2352x1568
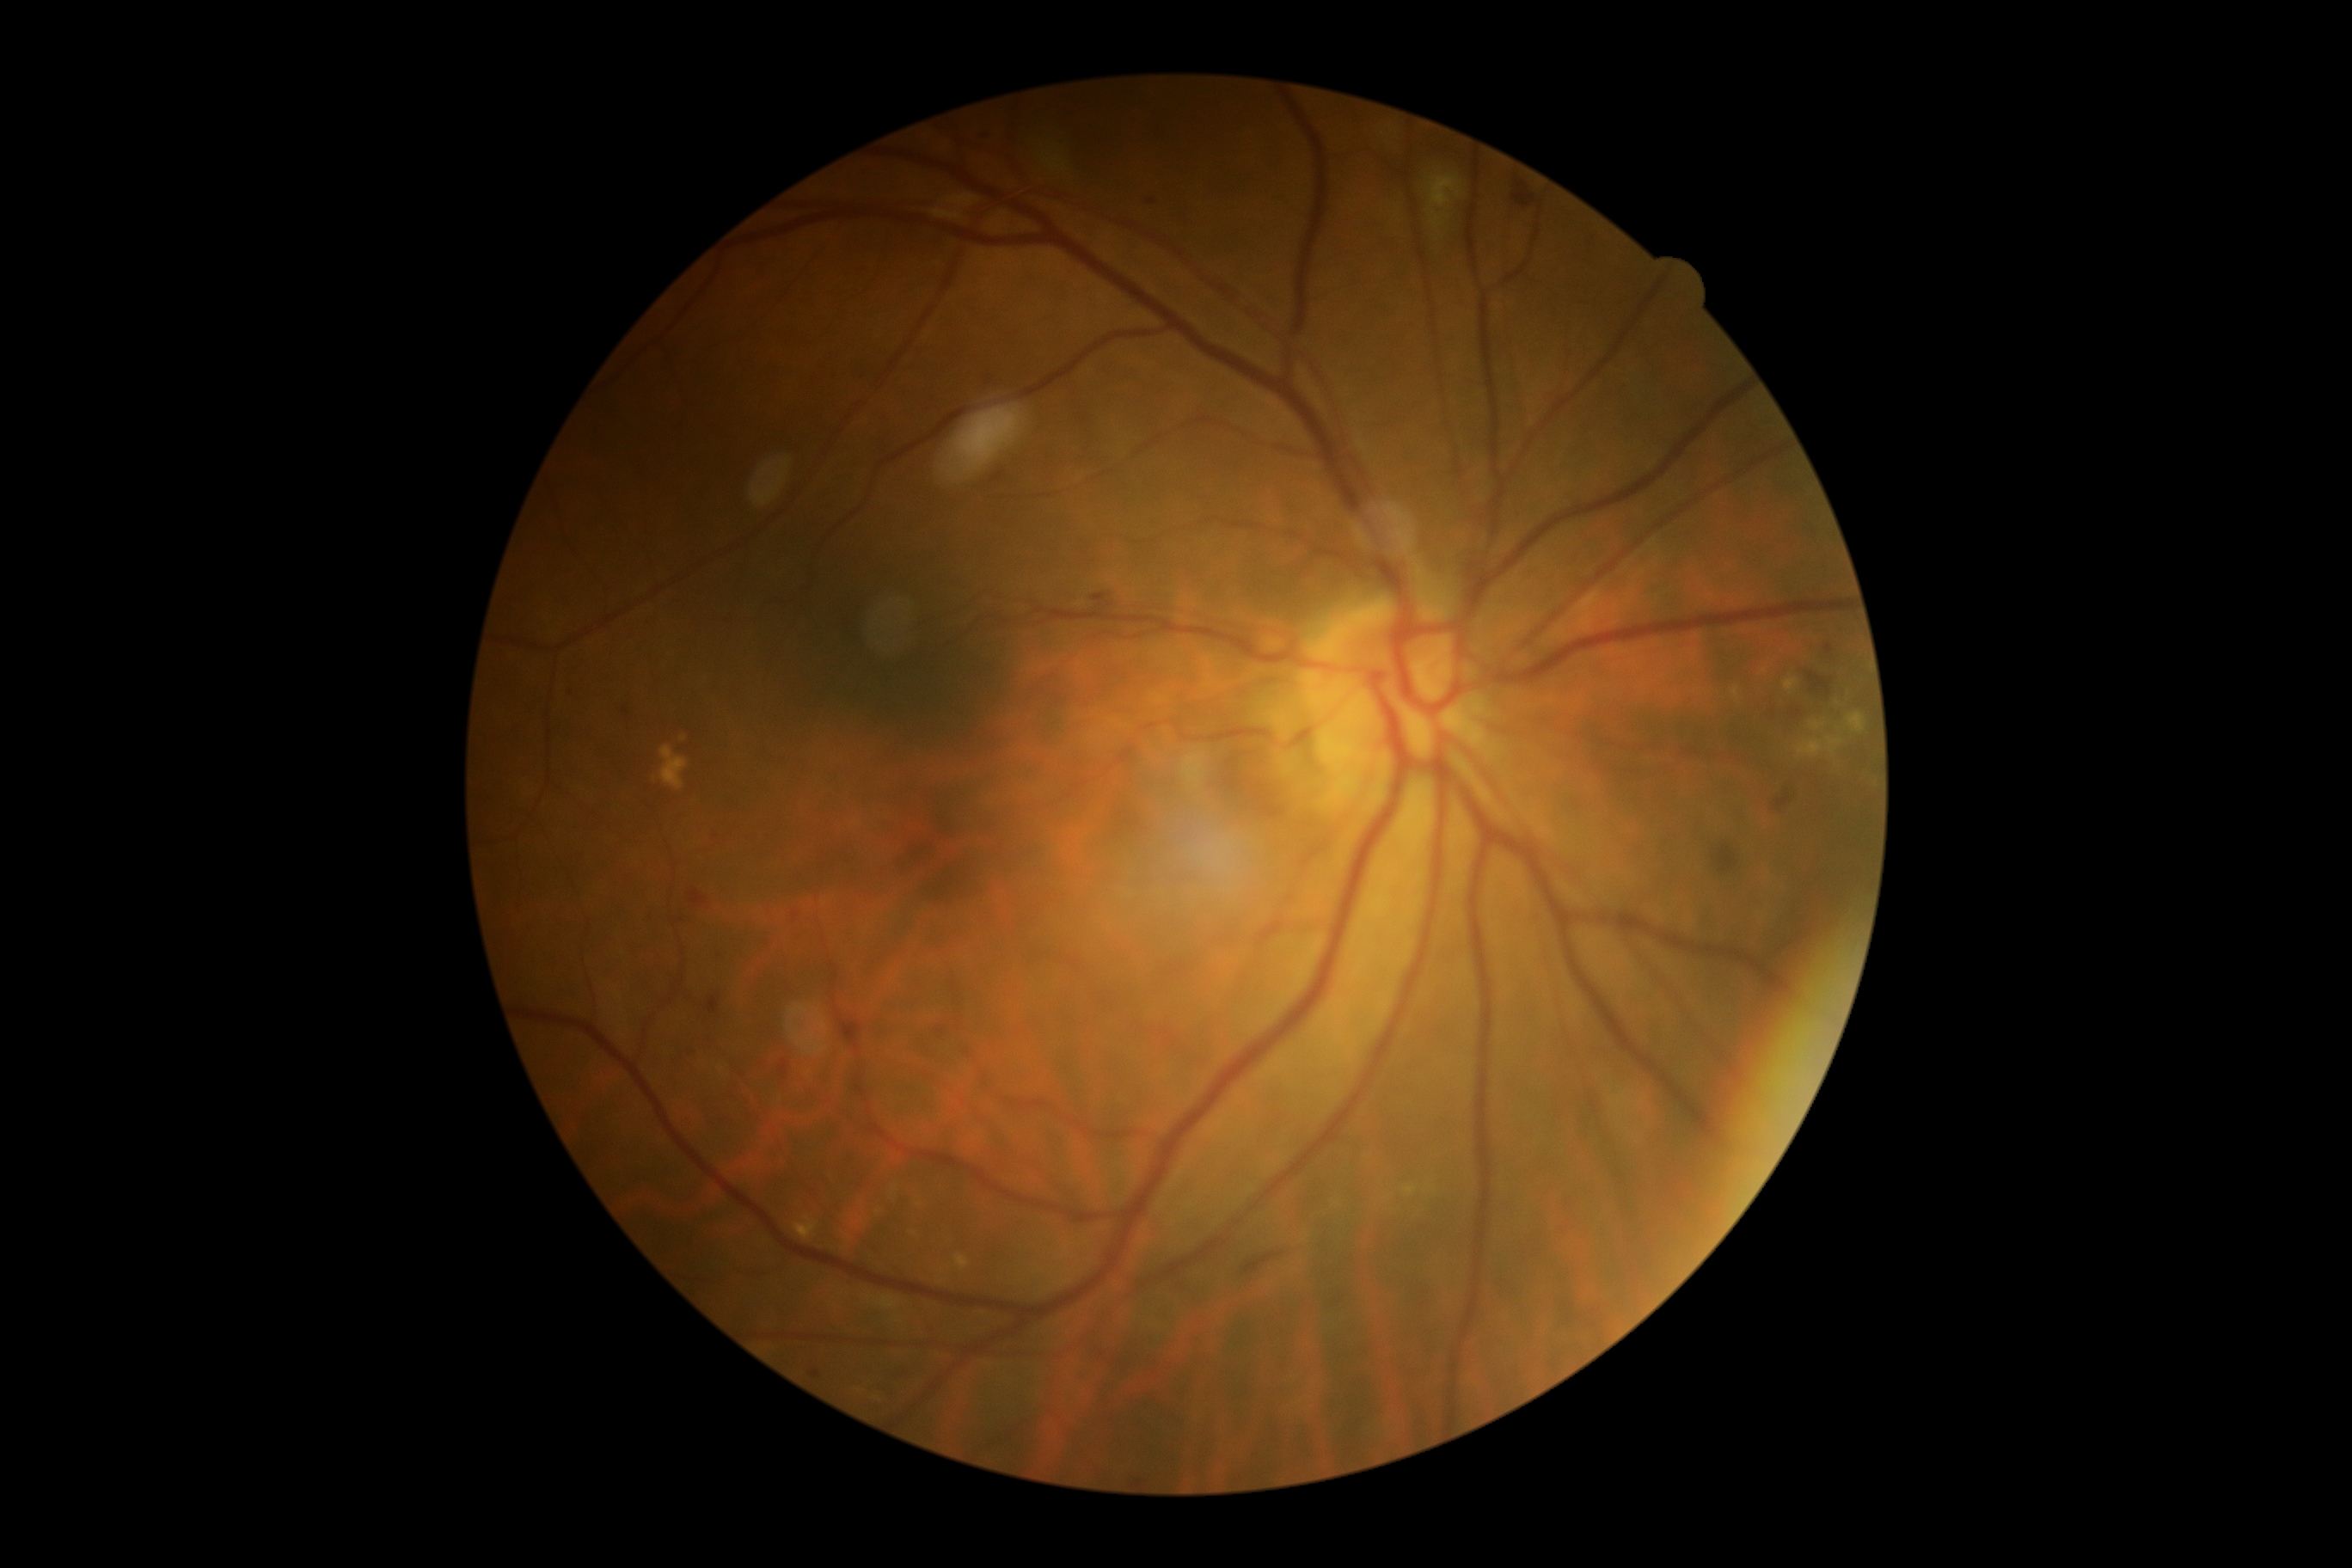 DR grade is 2.